Image size 2352x1568. FOV: 45 degrees
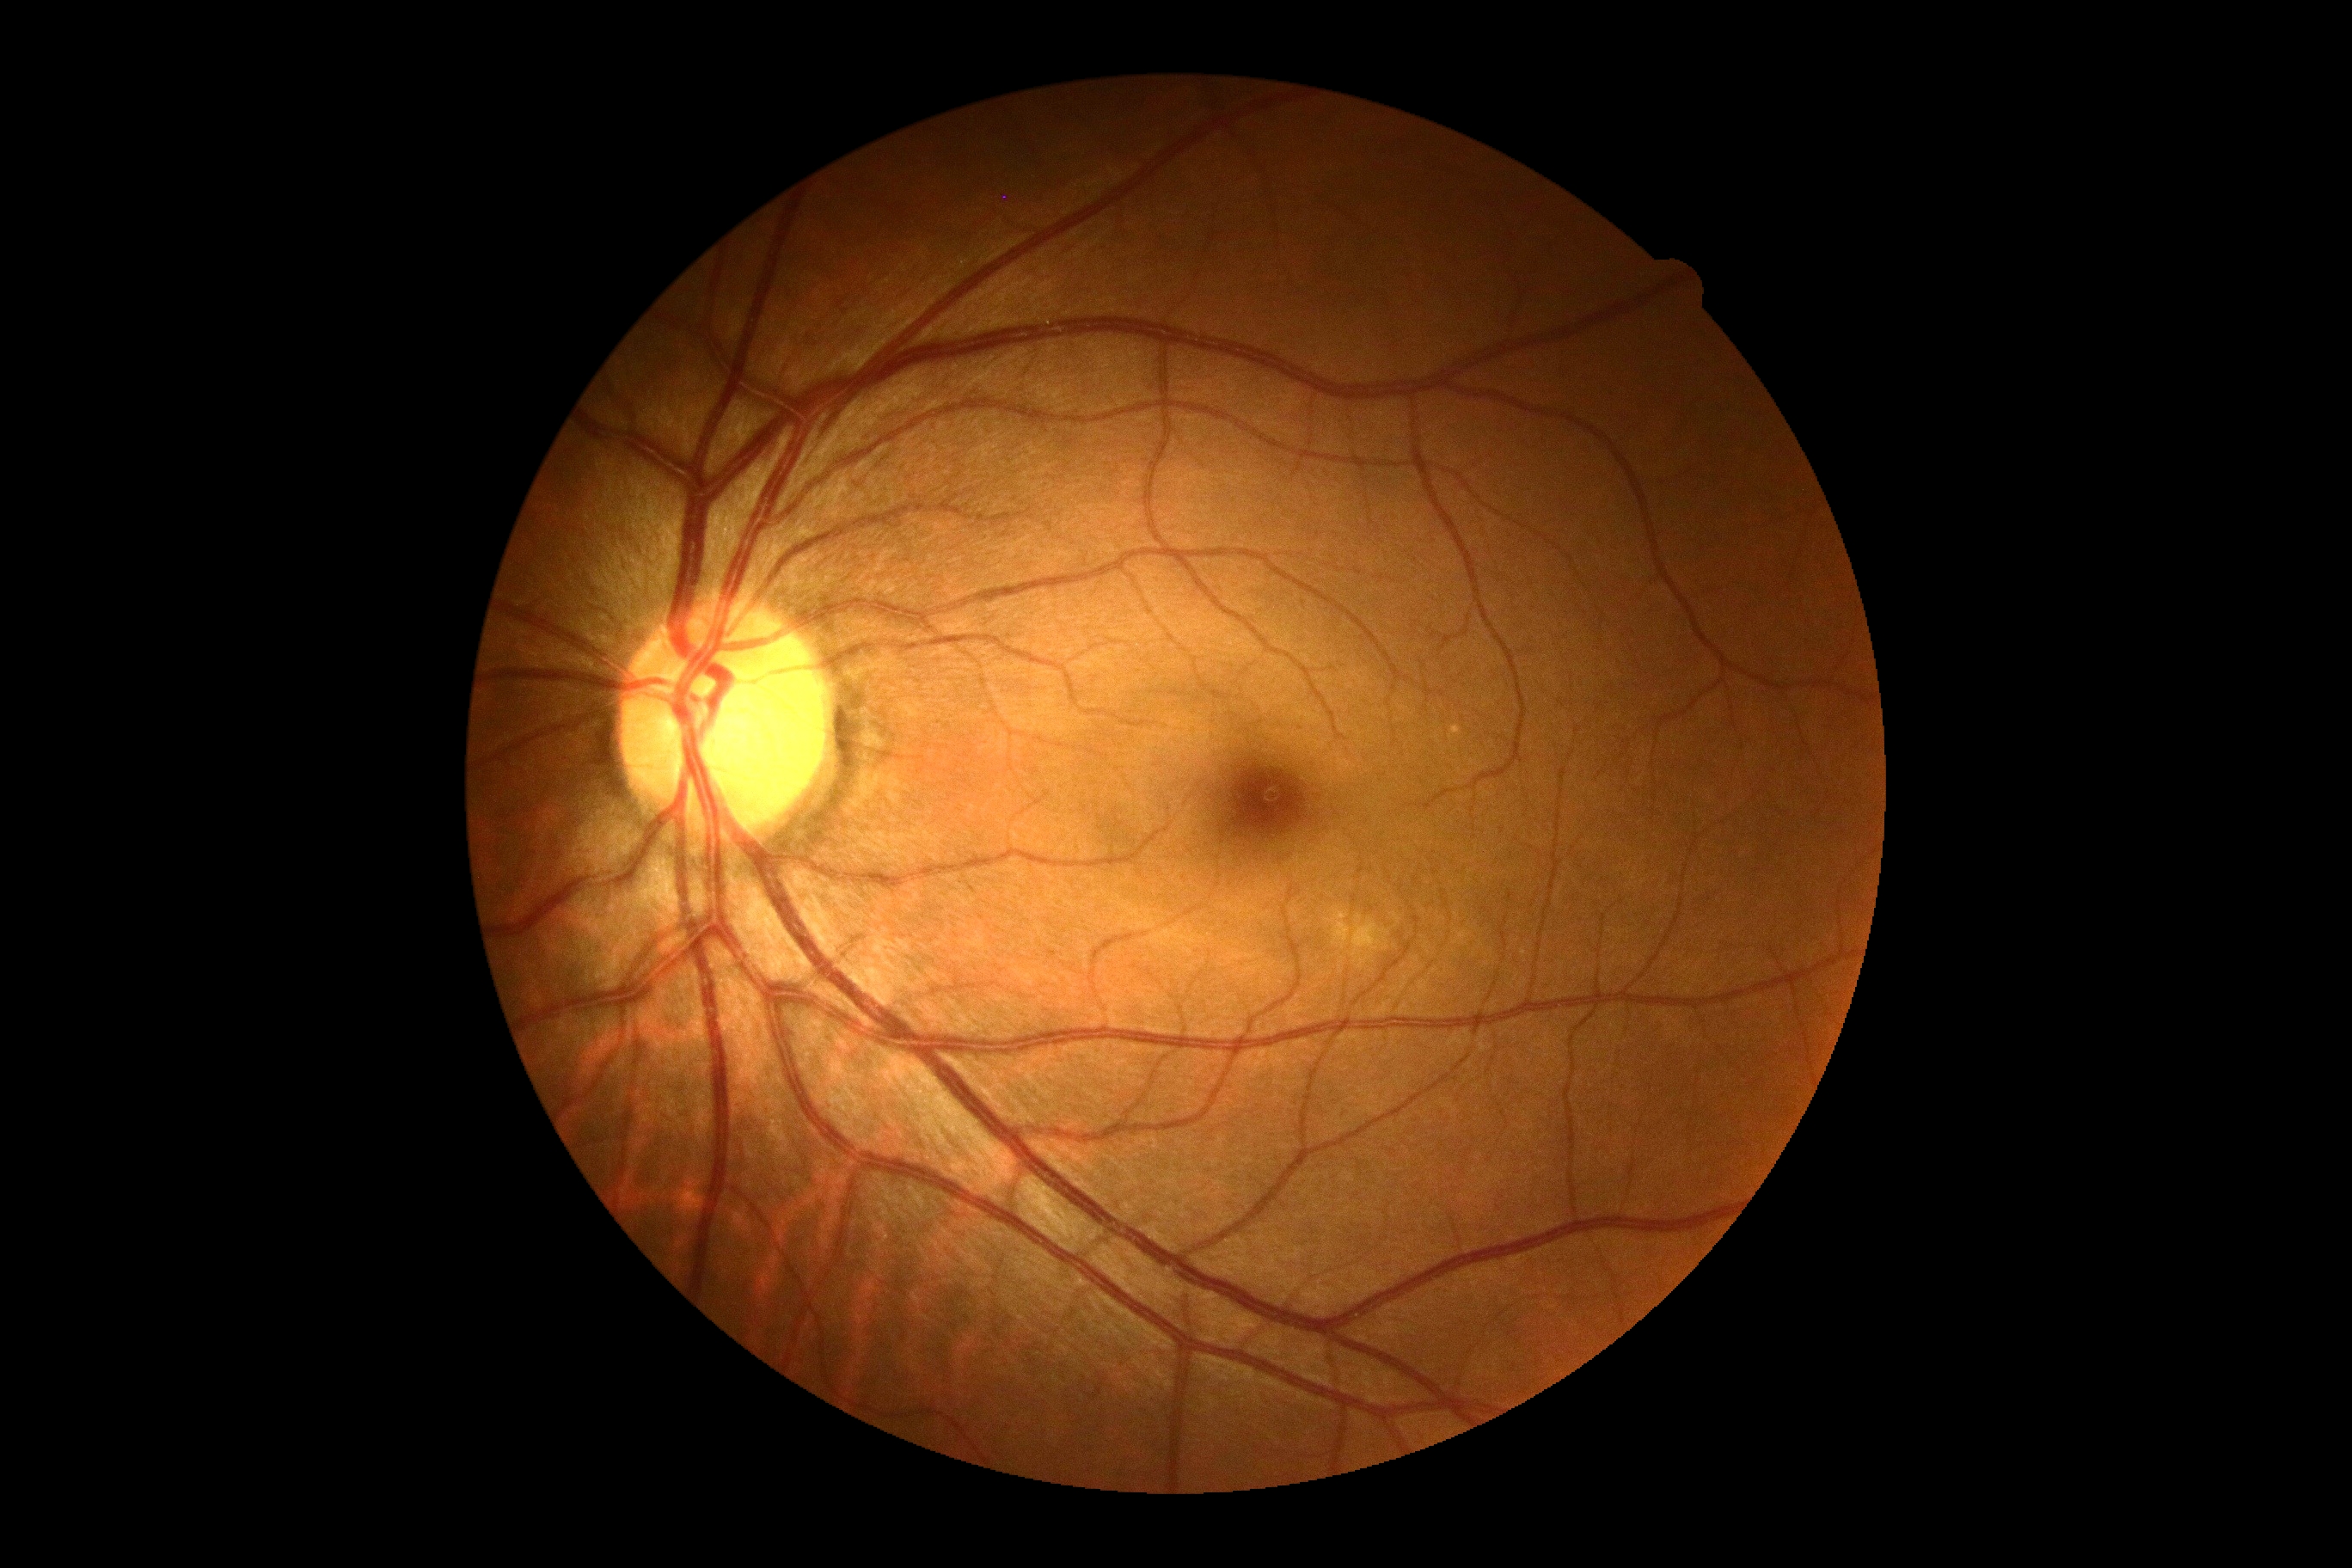
diabetic retinopathy (DR) = no apparent retinopathy (grade 0)
DR impression = no apparent DR